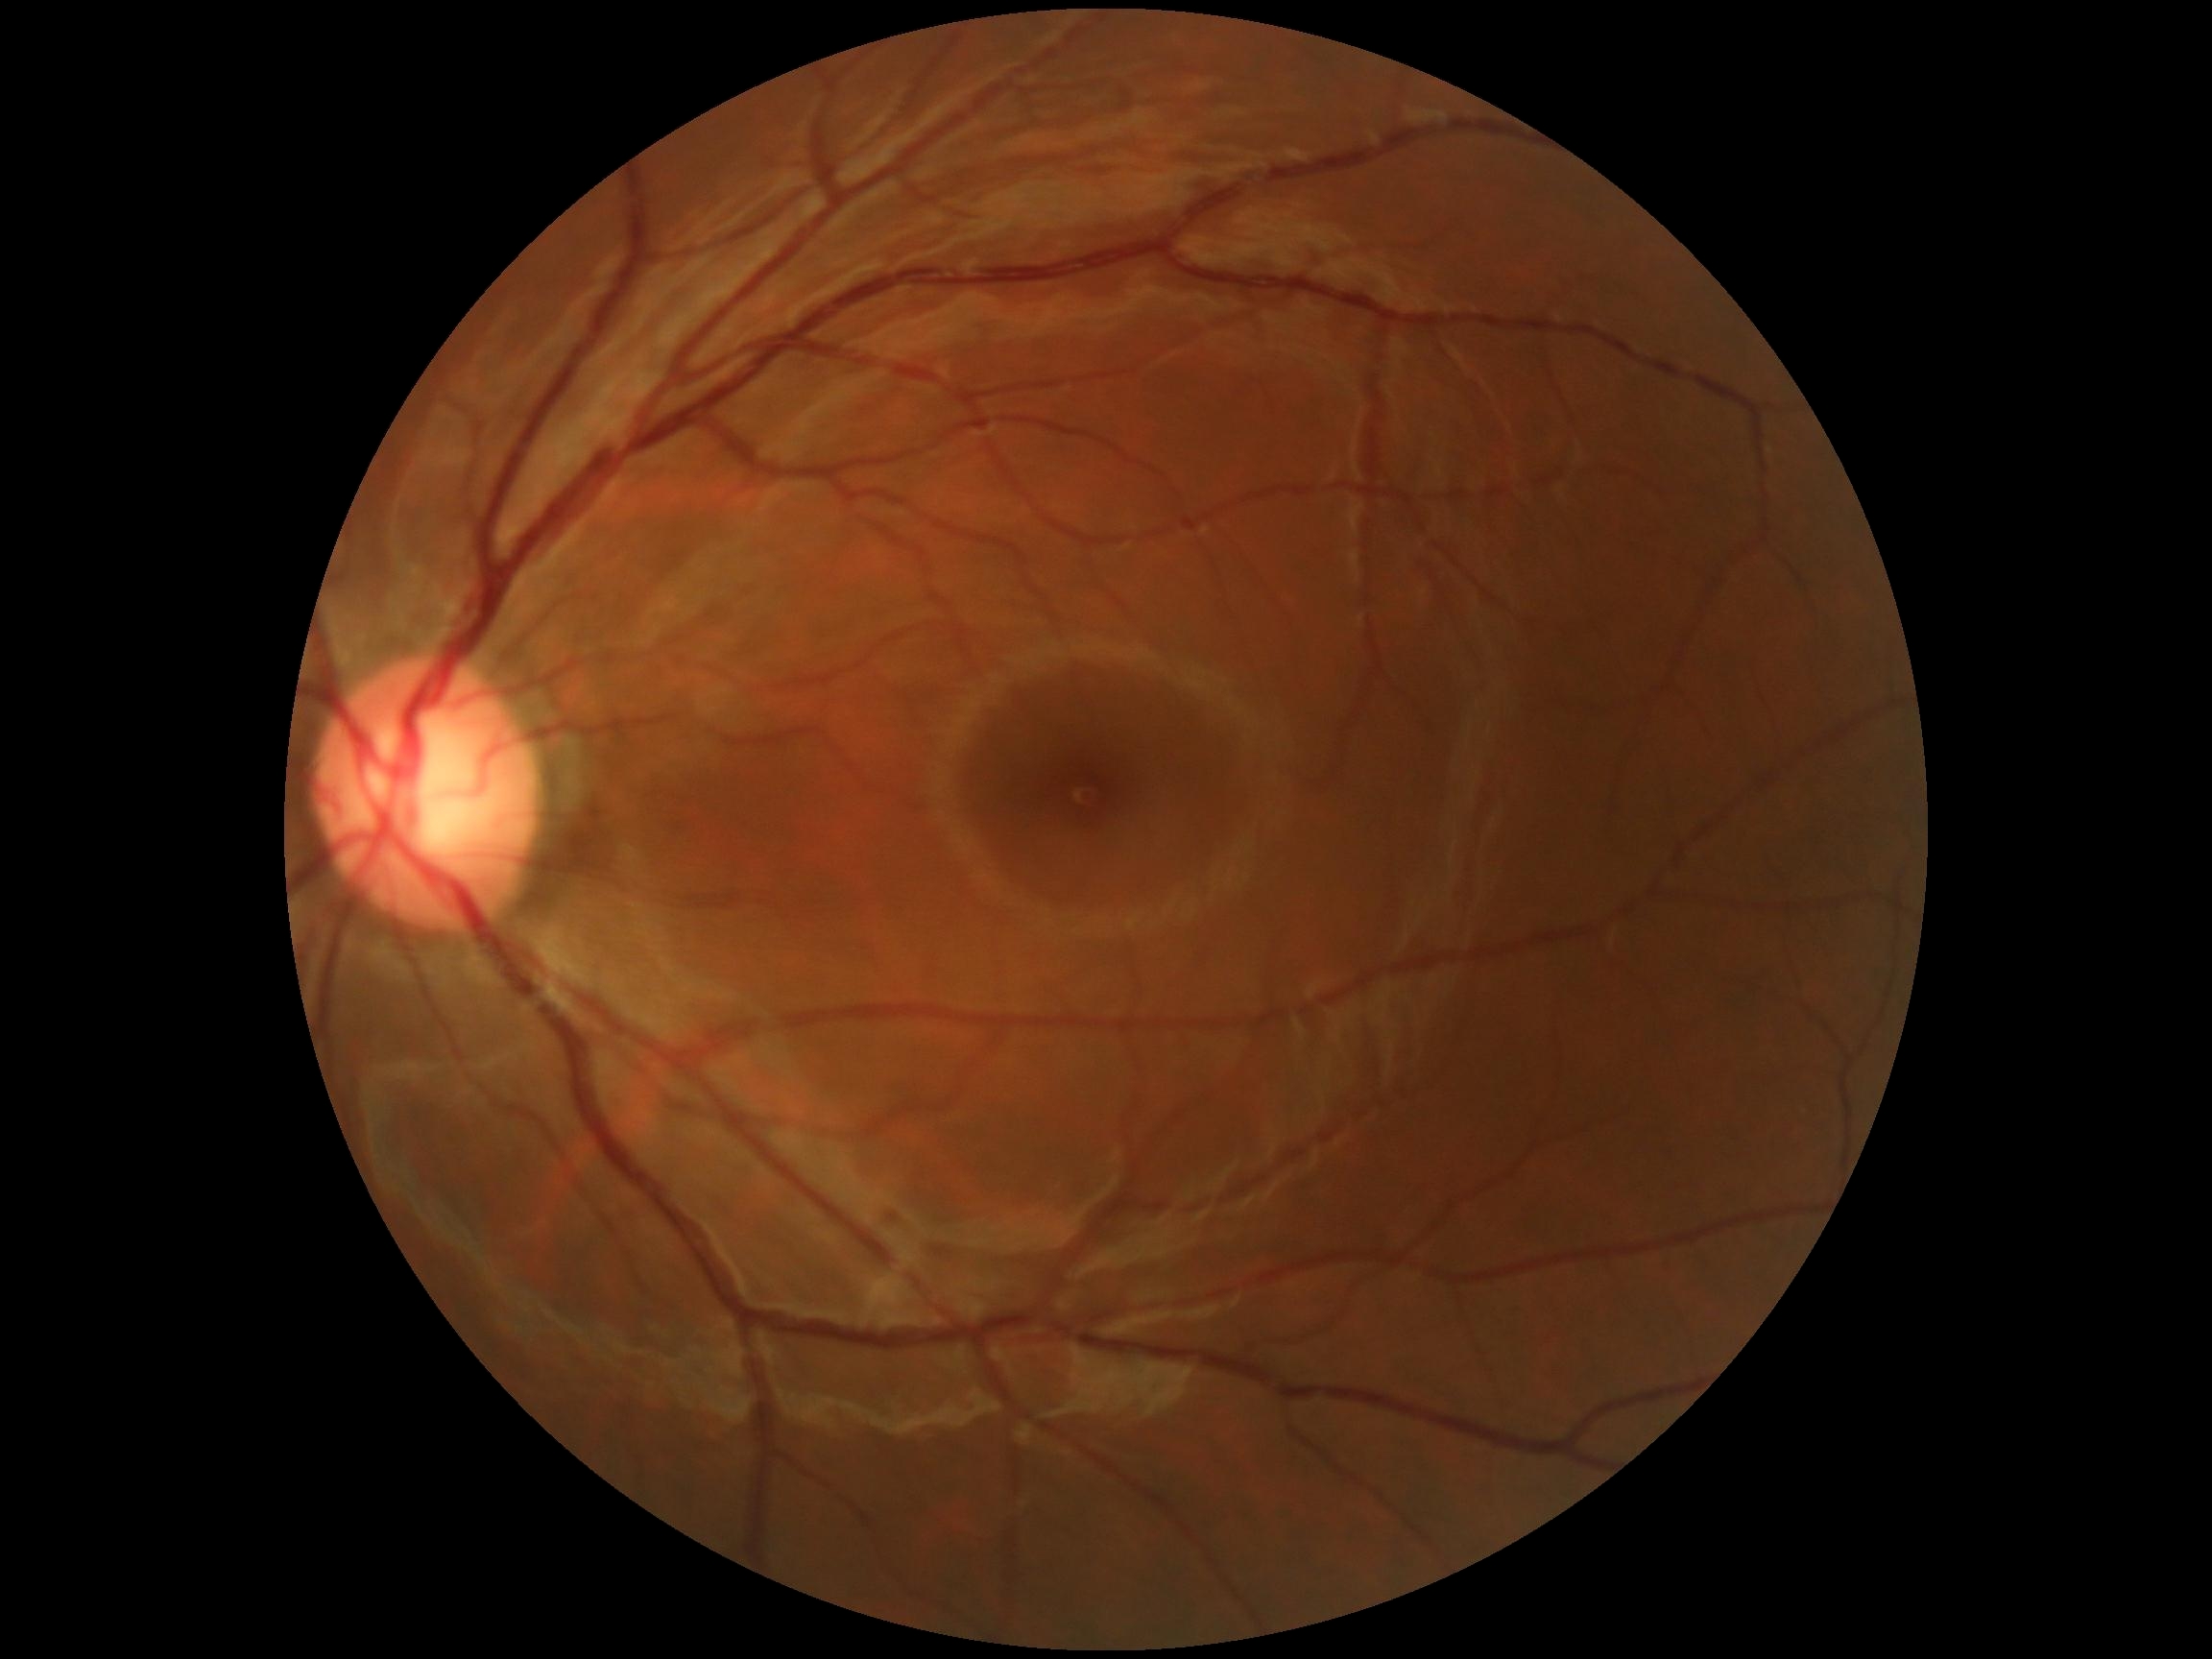
DR grade is 0 (no apparent retinopathy) — no visible signs of diabetic retinopathy.